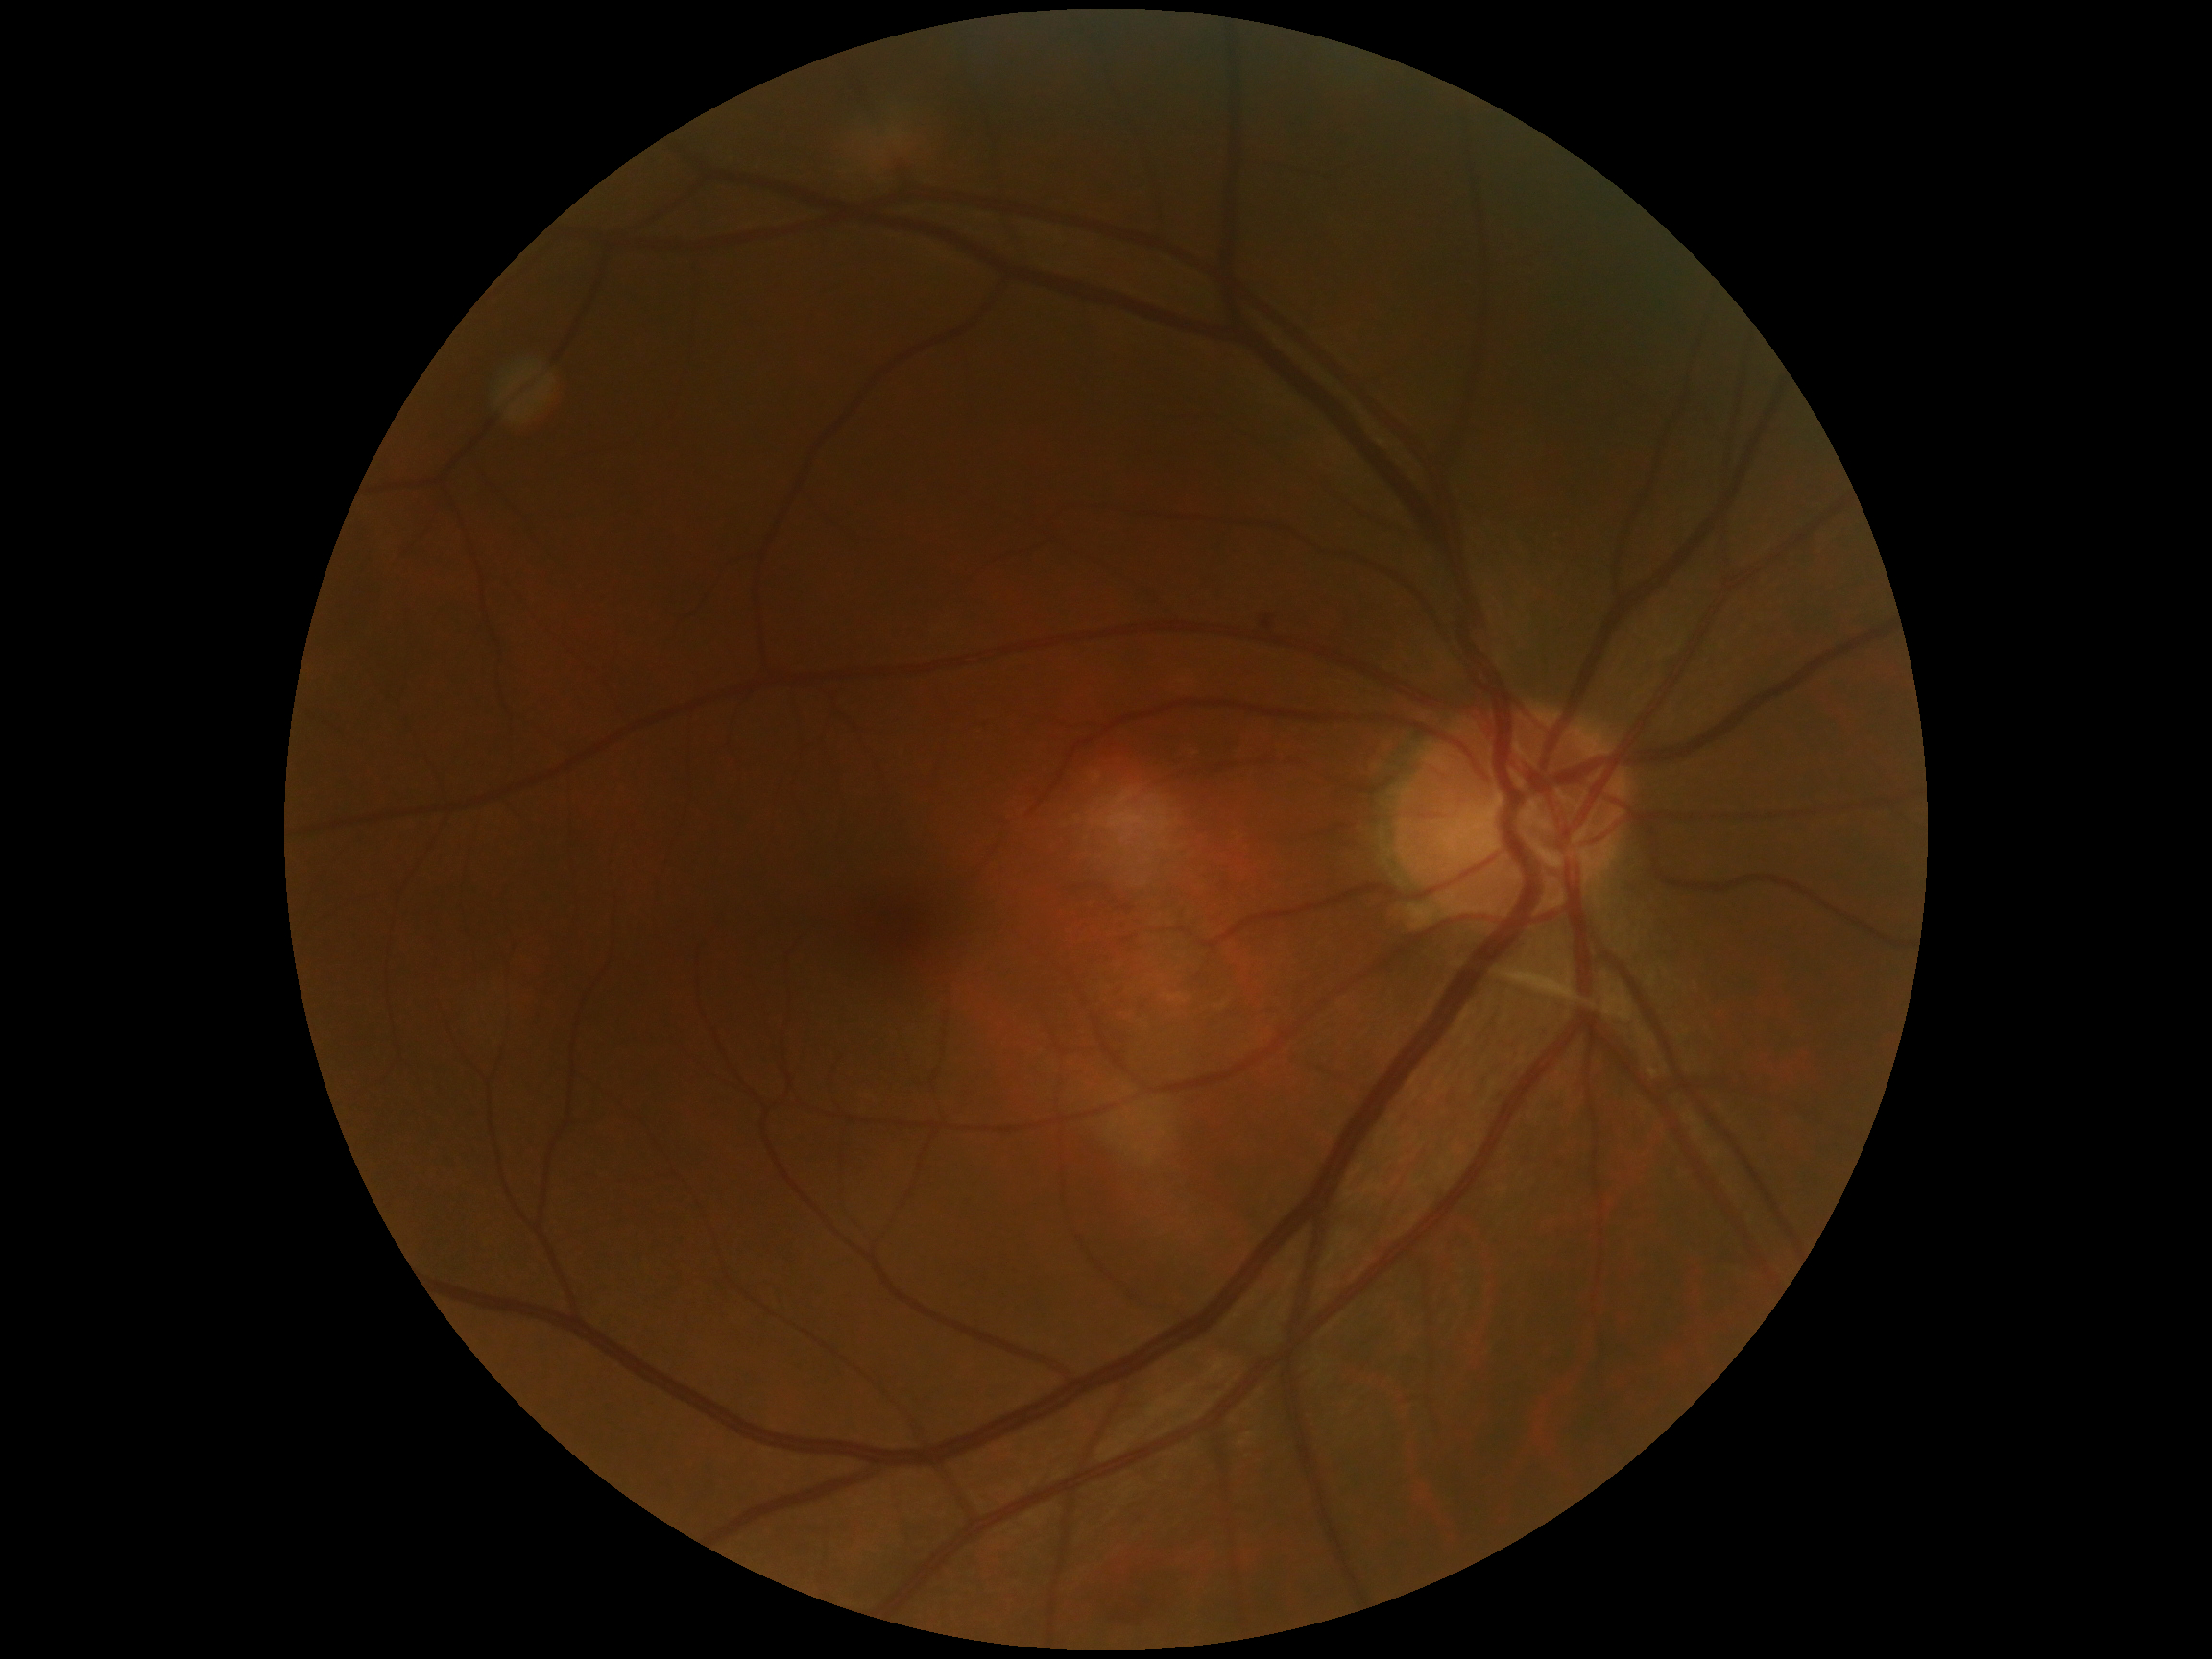

Diabetic retinopathy is 1. Disease class: non-proliferative diabetic retinopathy.